CFP:
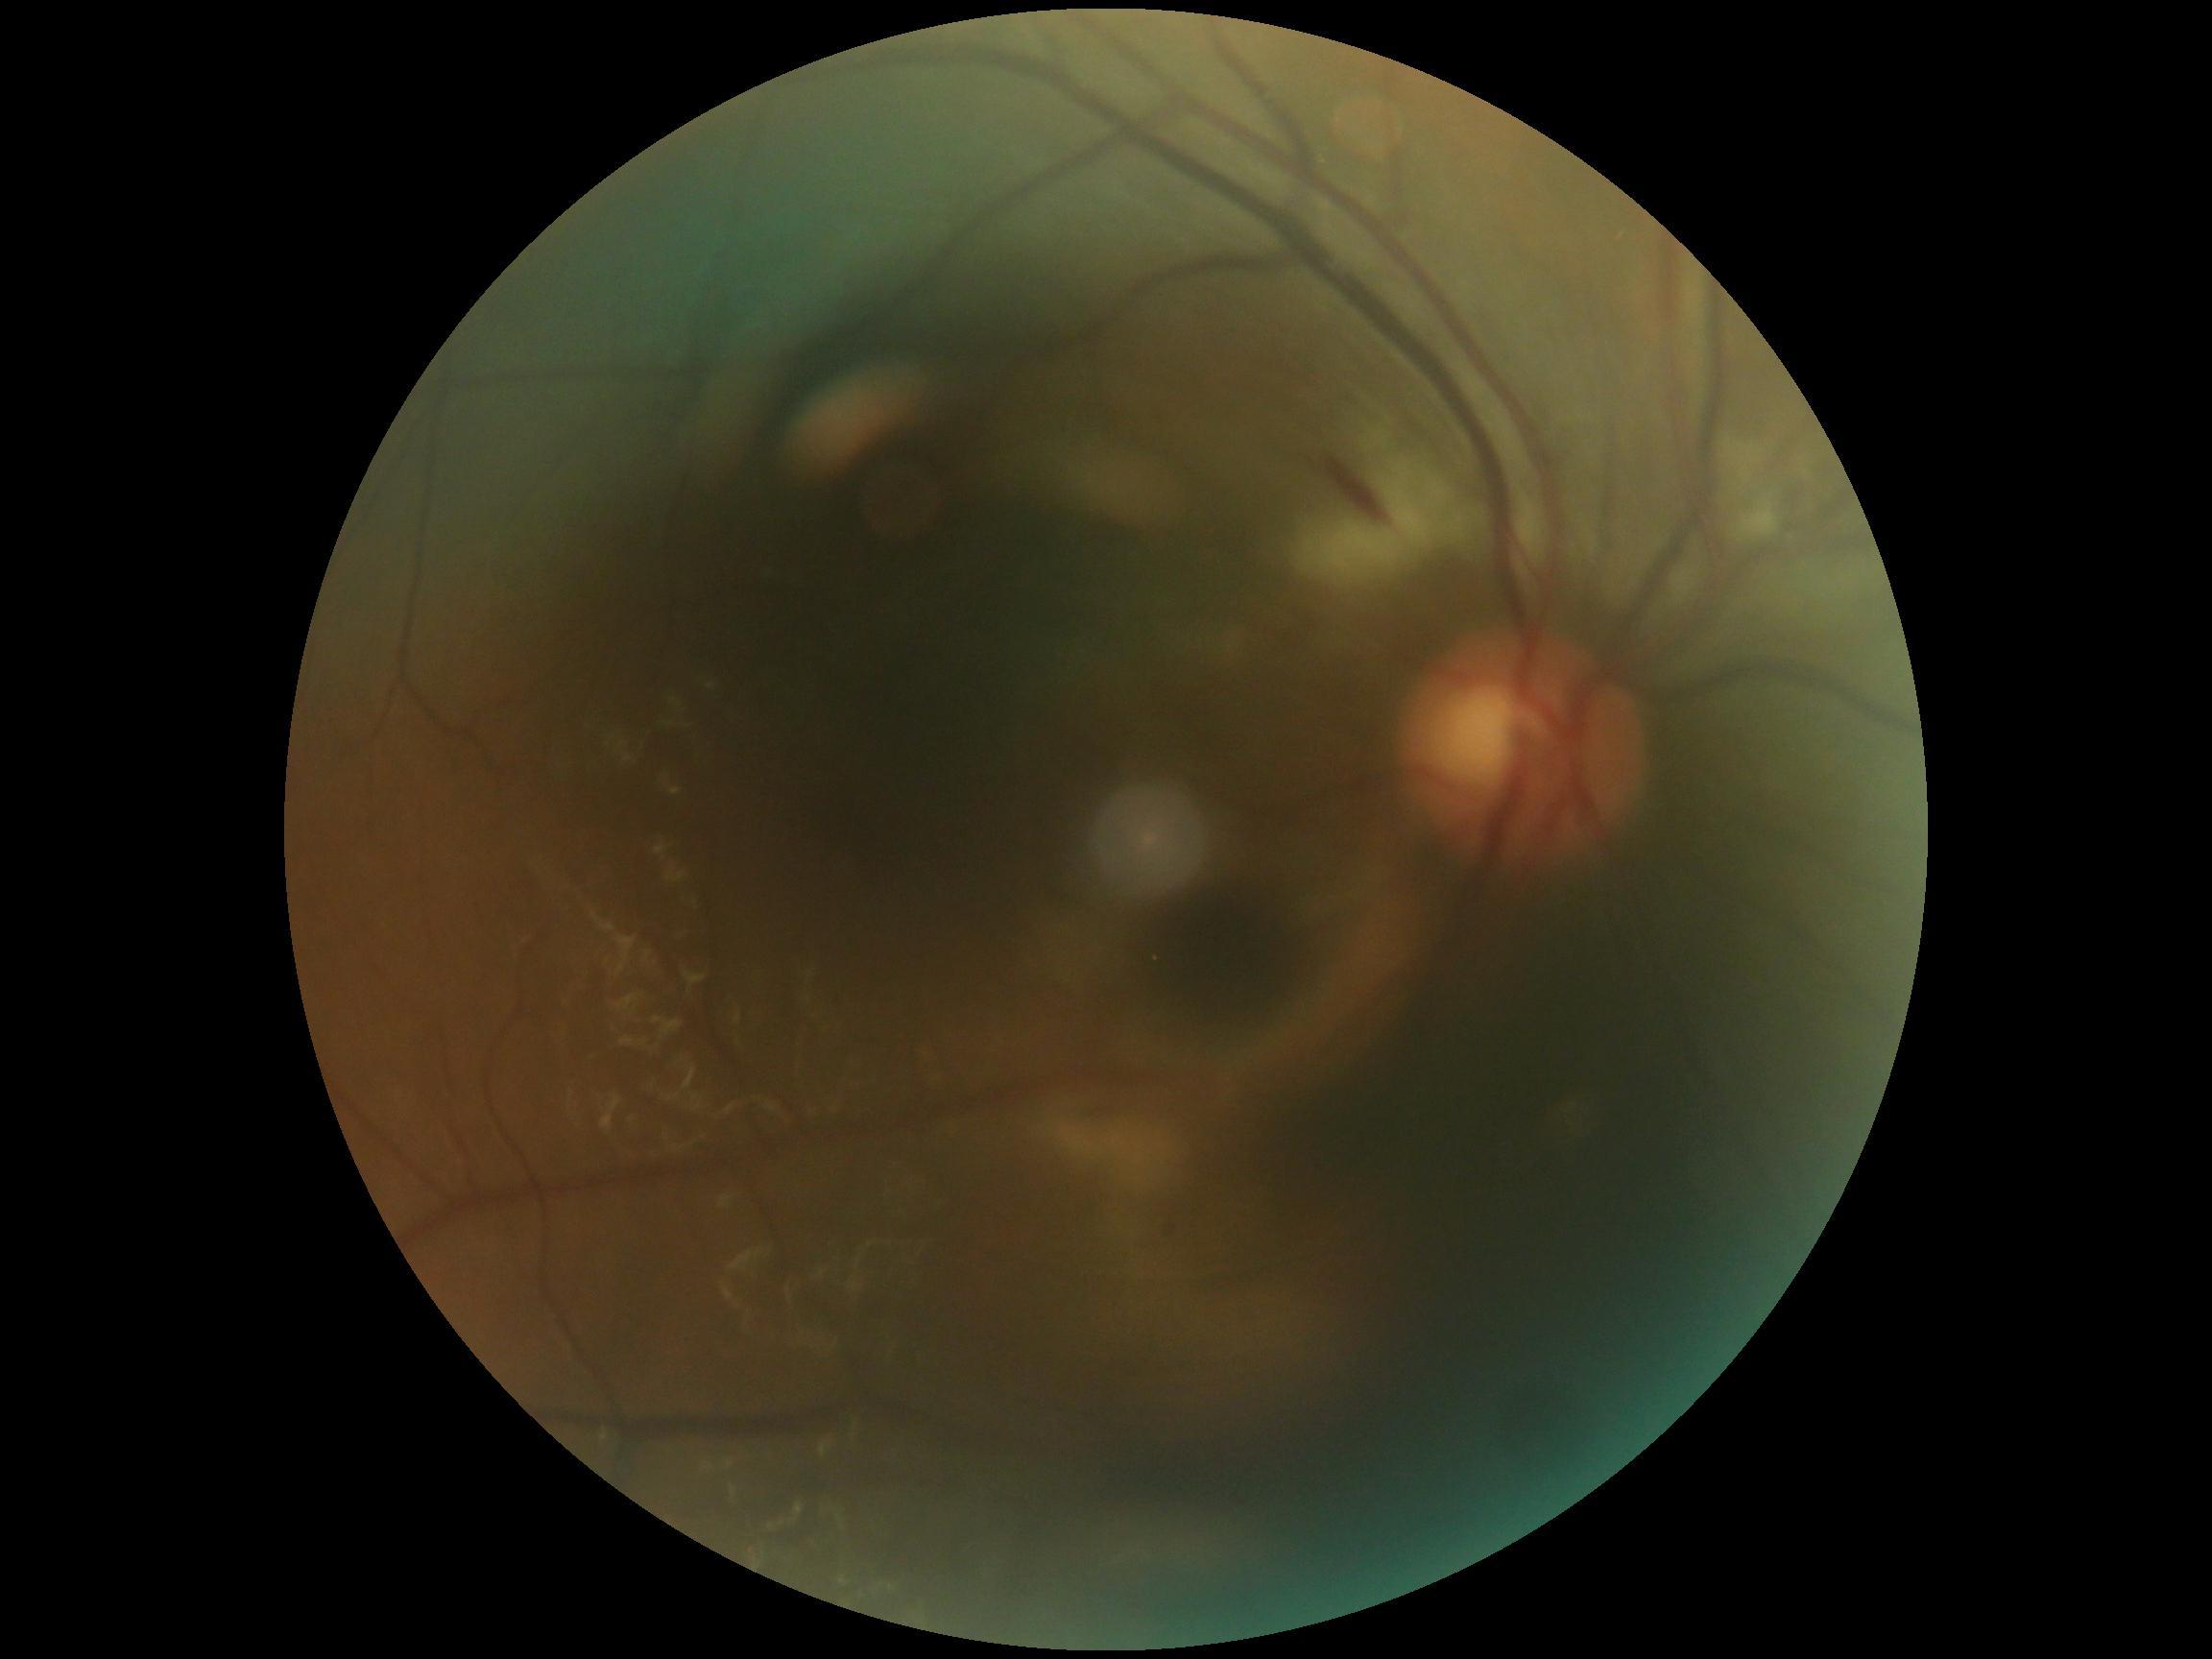
DR class=non-proliferative diabetic retinopathy, diabetic retinopathy (DR)=2/4.